45° FOV; 2212x1659px:
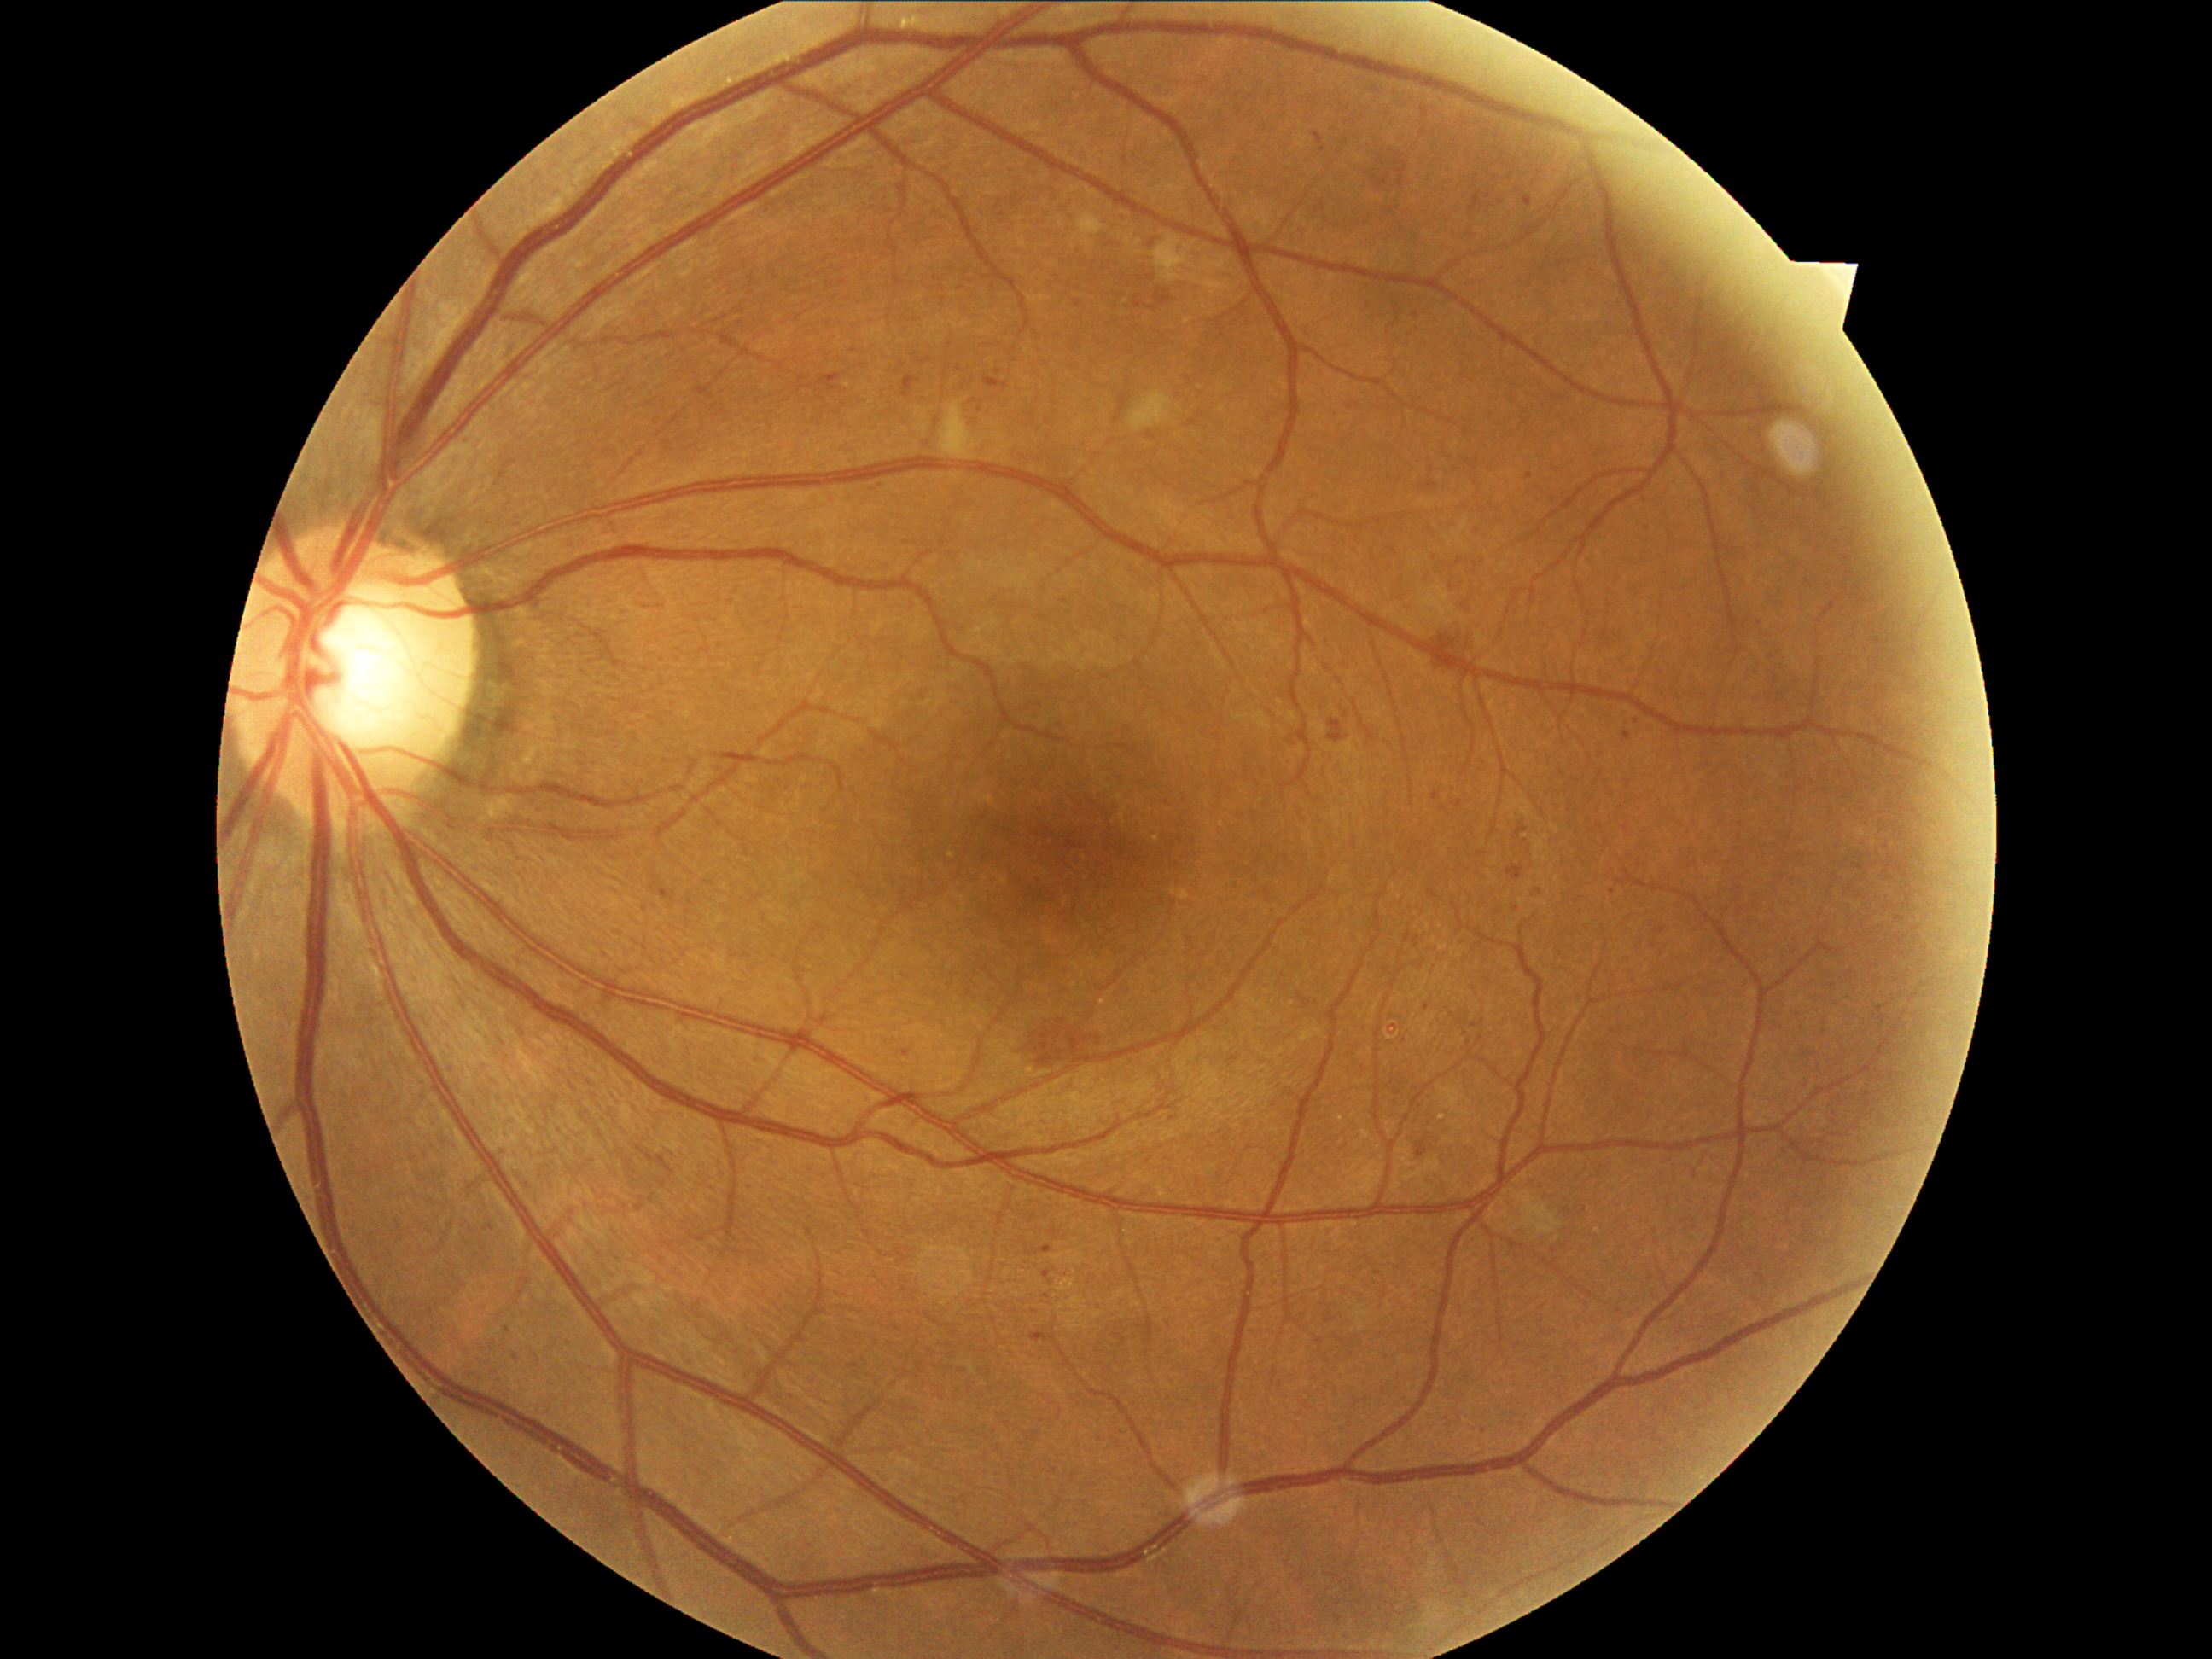
{"dr_grade": "moderate NPDR (grade 2) — more than just microaneurysms but less than severe NPDR"}